Pediatric retinal photograph (wide-field): 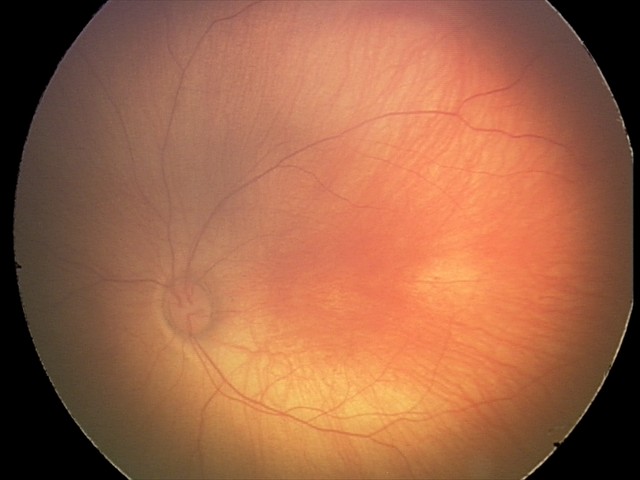 From an examination with diagnosis of retinal hemorrhages.